45-degree field of view. CFP.
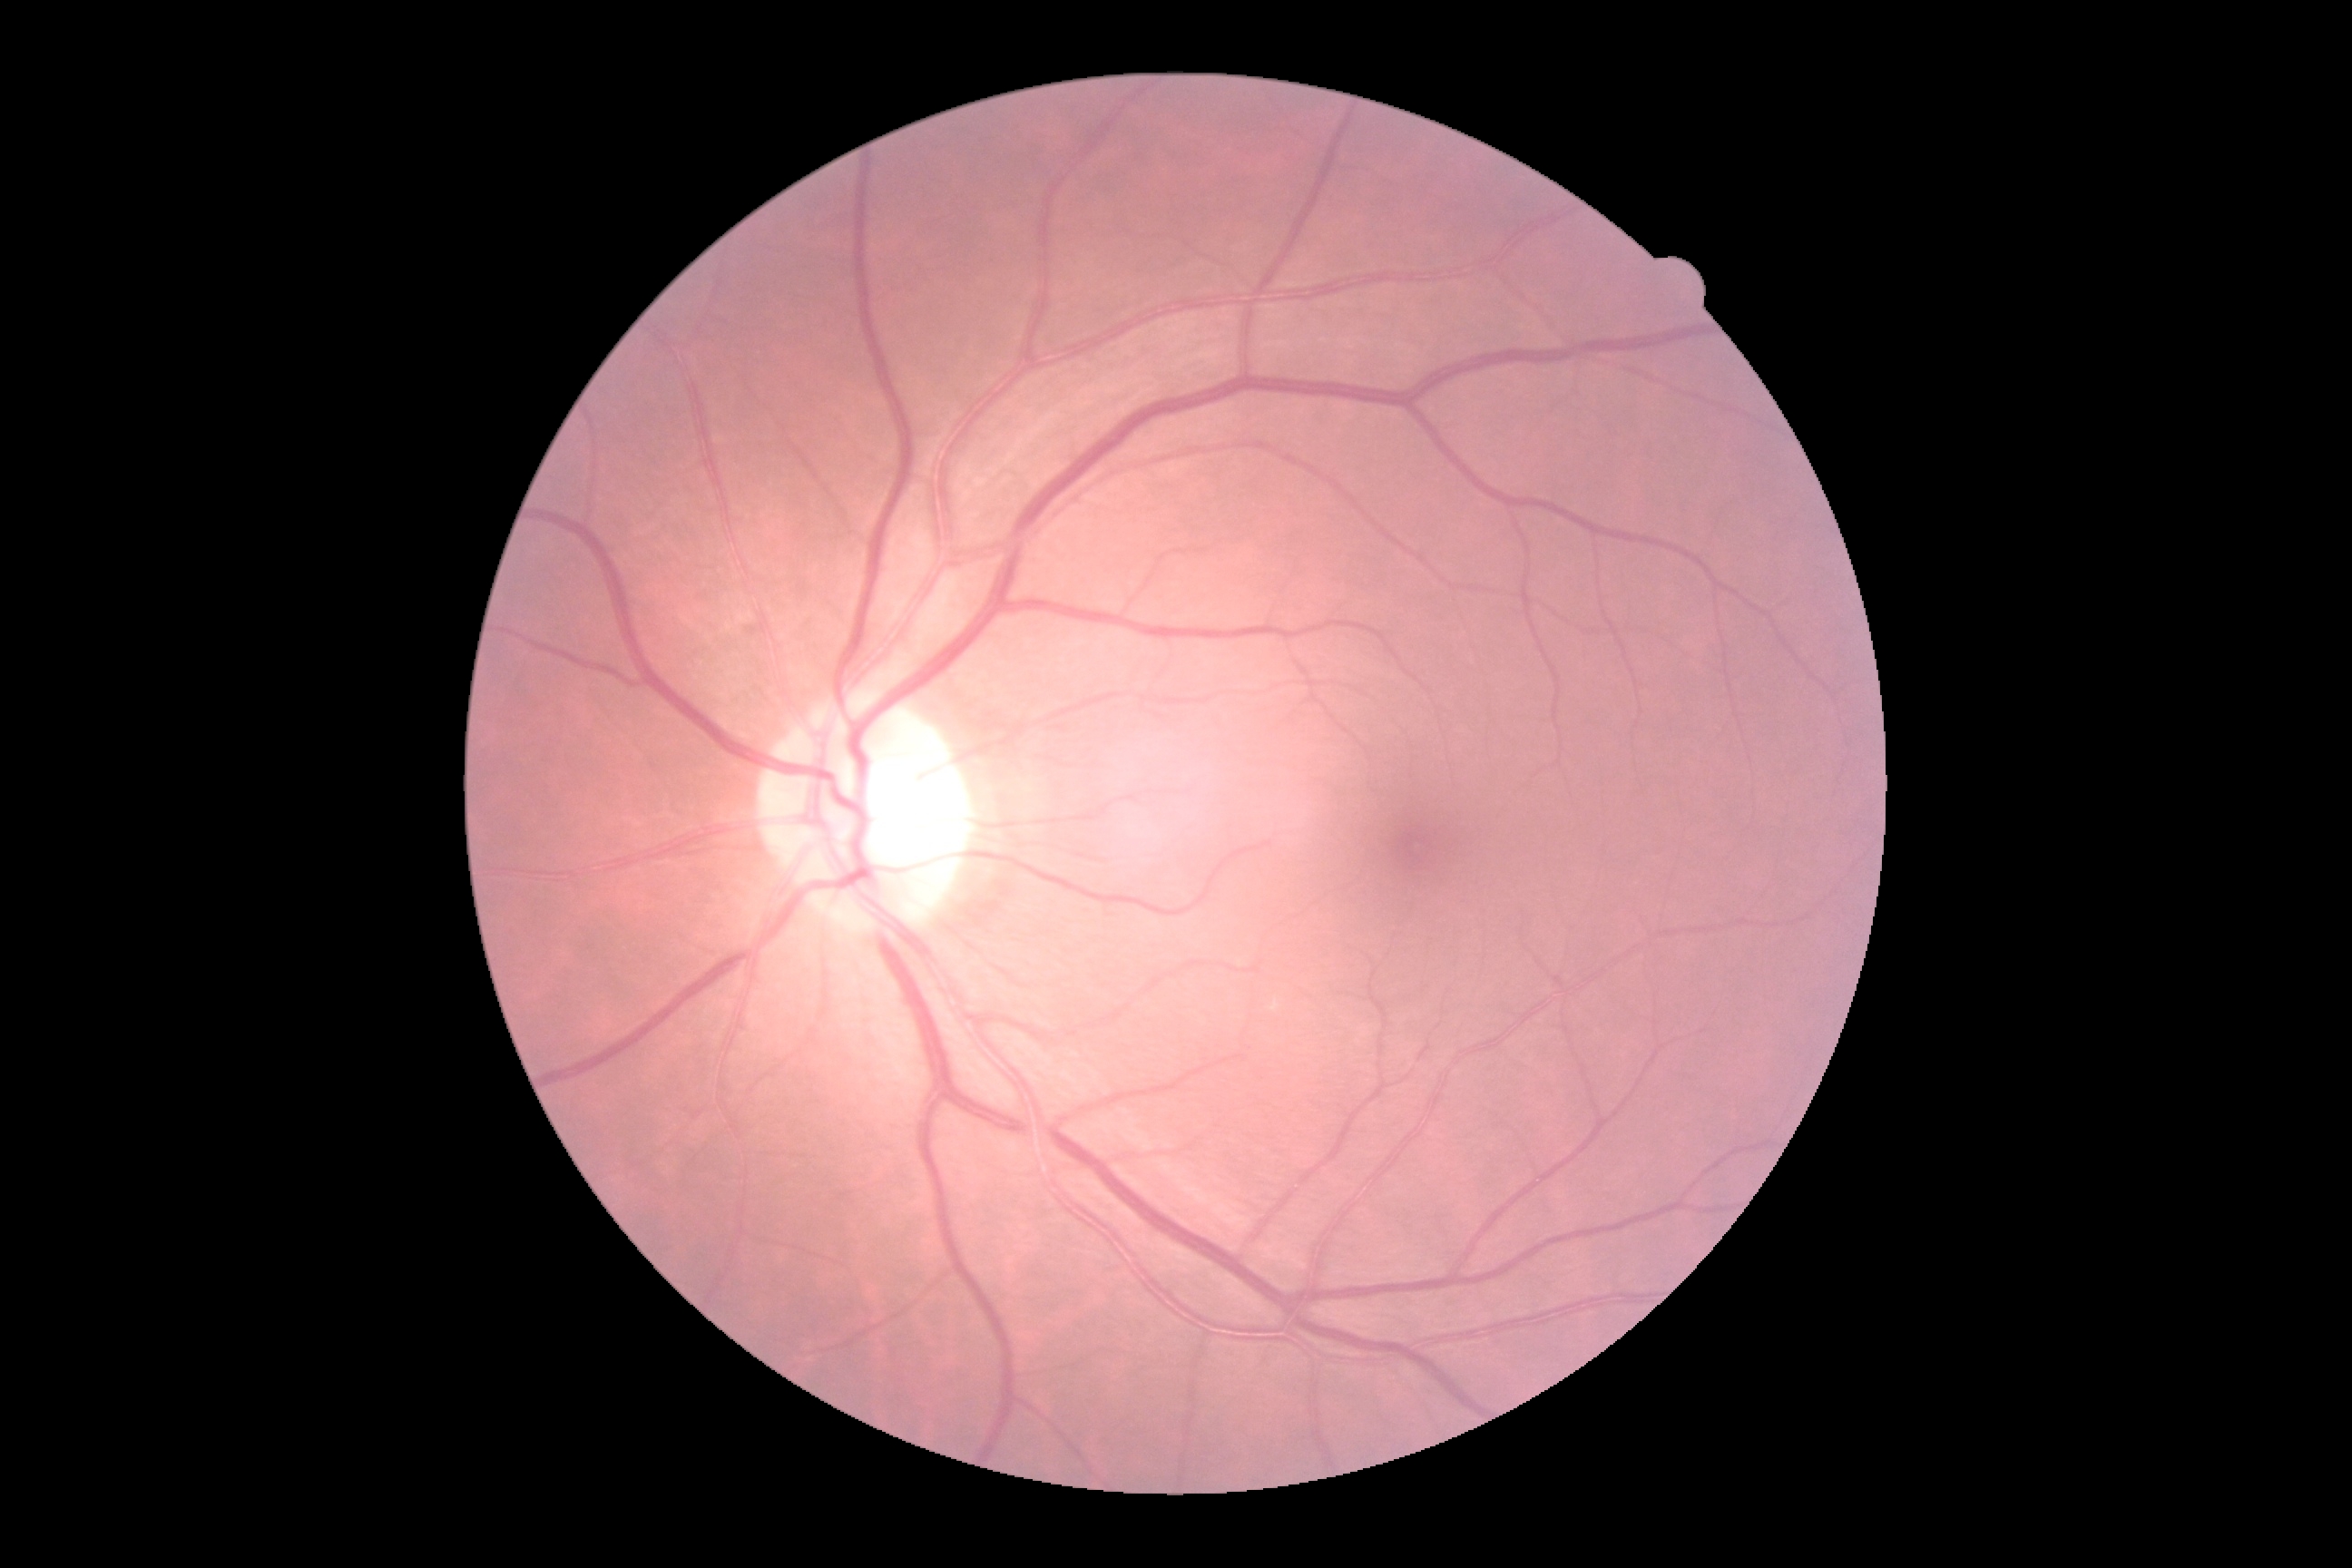
- DR impression: no apparent DR
- DR: 0/4